1240x1240px. Wide-field fundus photograph of an infant:
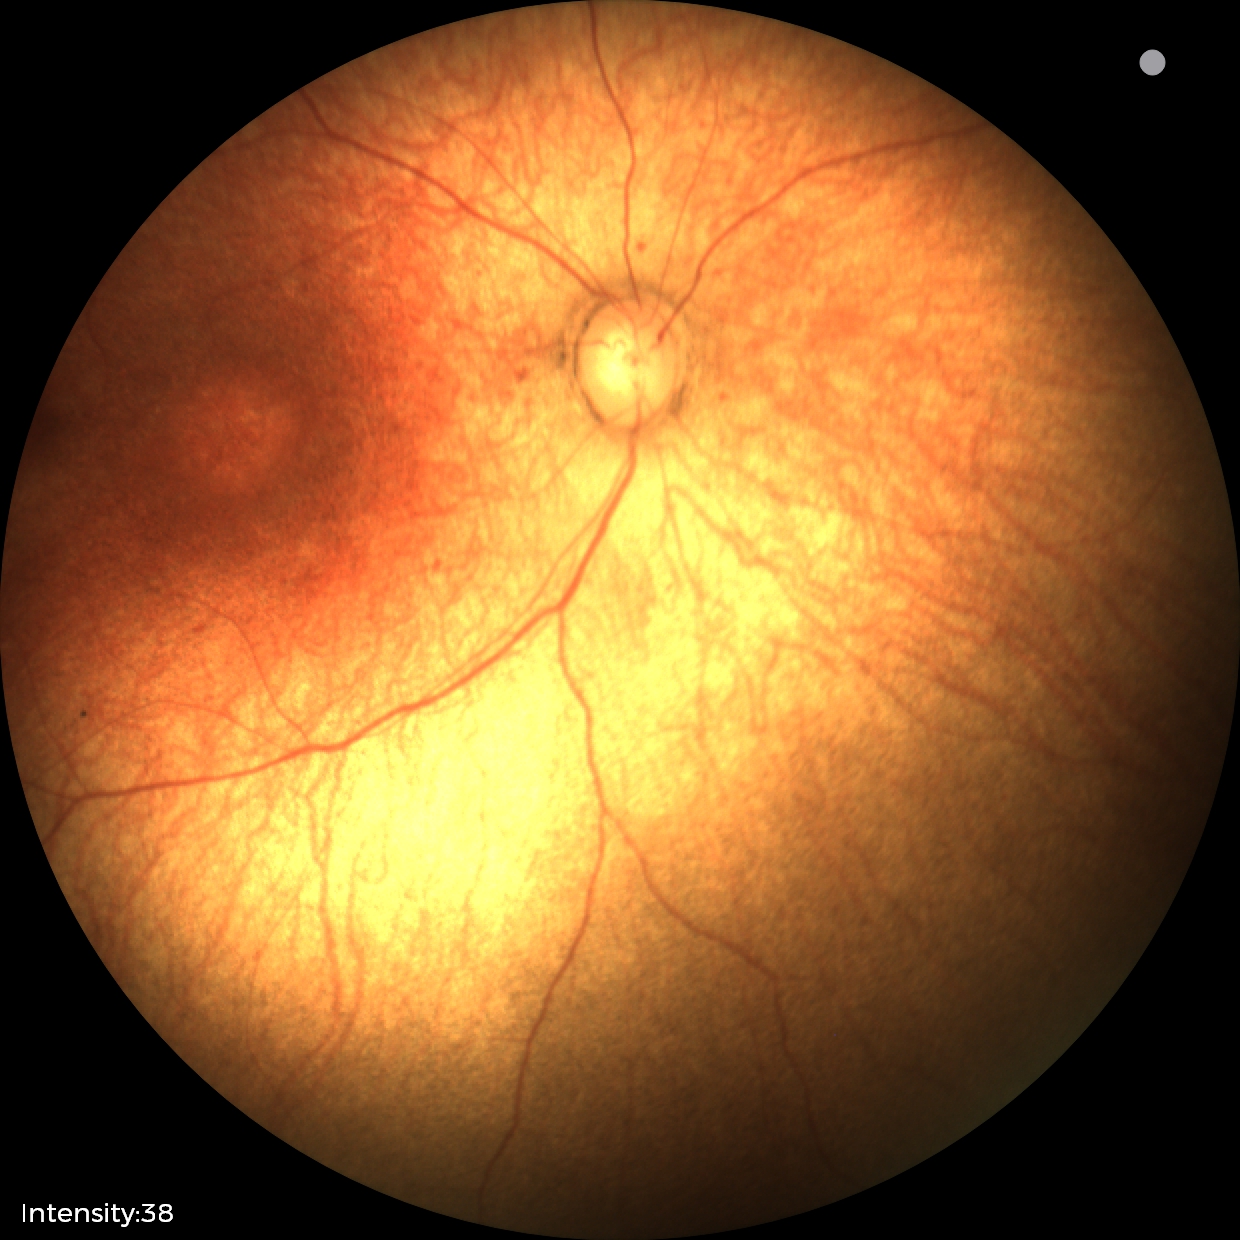 Physiological retinal appearance for postconceptual age.